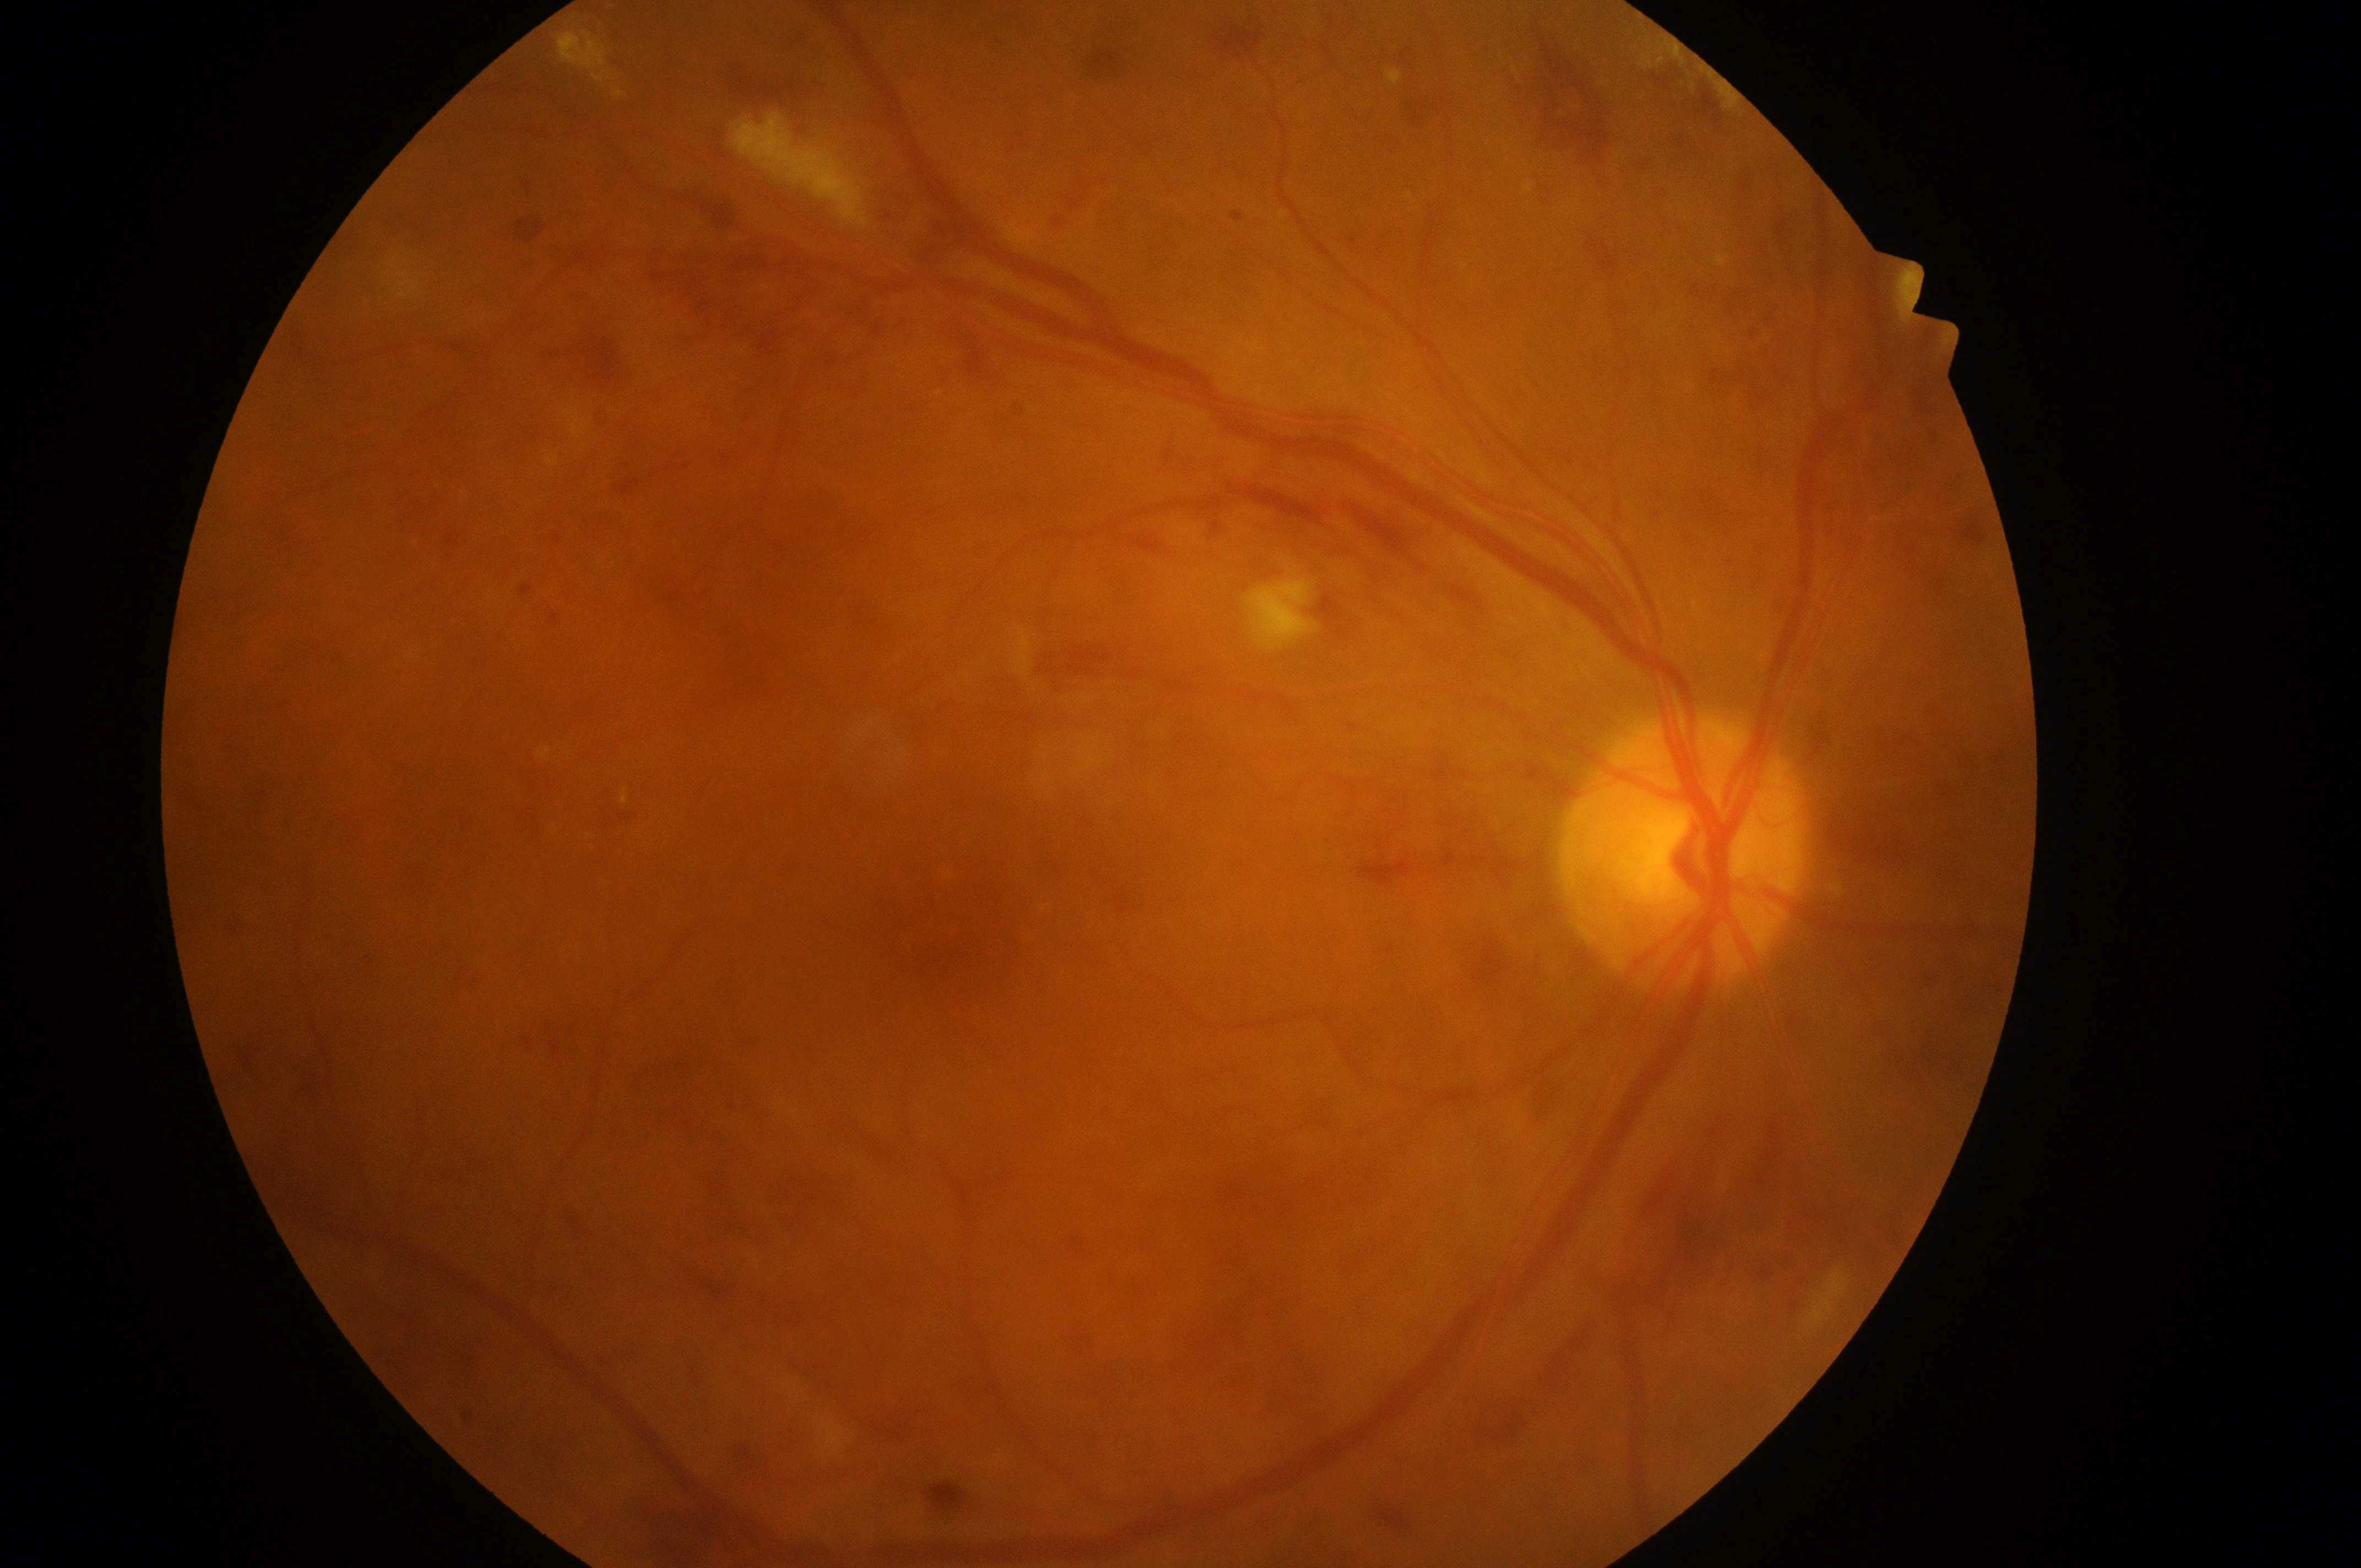
laterality = oculus dexter
foveal center = [955, 932]
DME risk = grade 2 (high risk)
the optic disc = [1681, 866]
DR severity = grade 4 (PDR)